848 by 848 pixels · graded on the modified Davis scale: 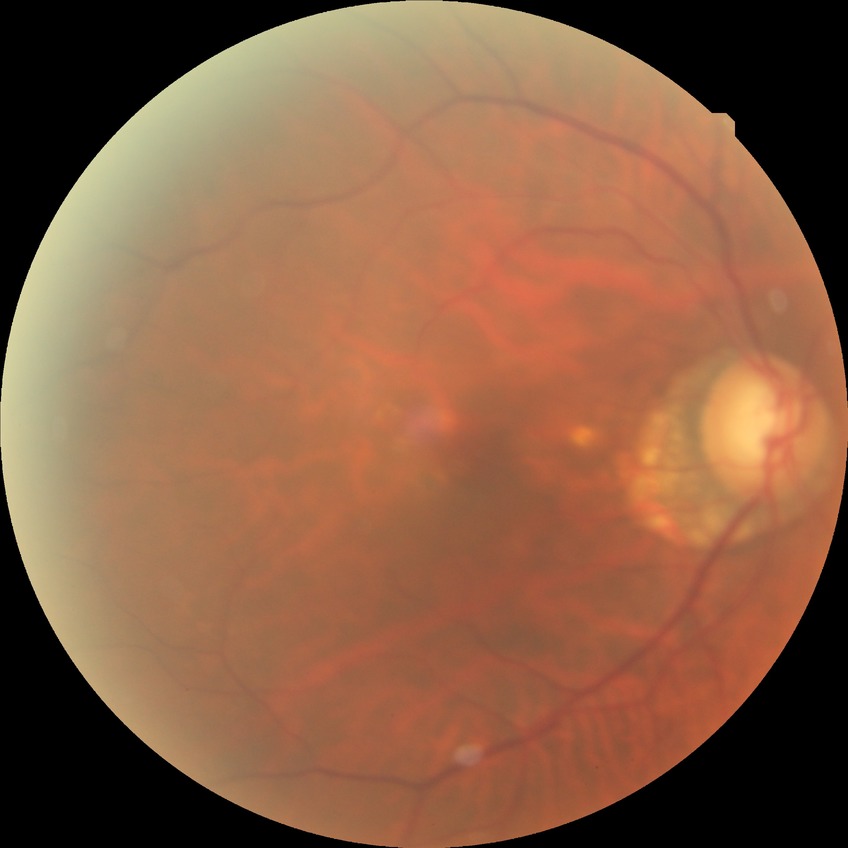
  davis_grade: no diabetic retinopathy (NDR)